Retinal fundus photograph · 848 x 848 pixels · without pupil dilation: 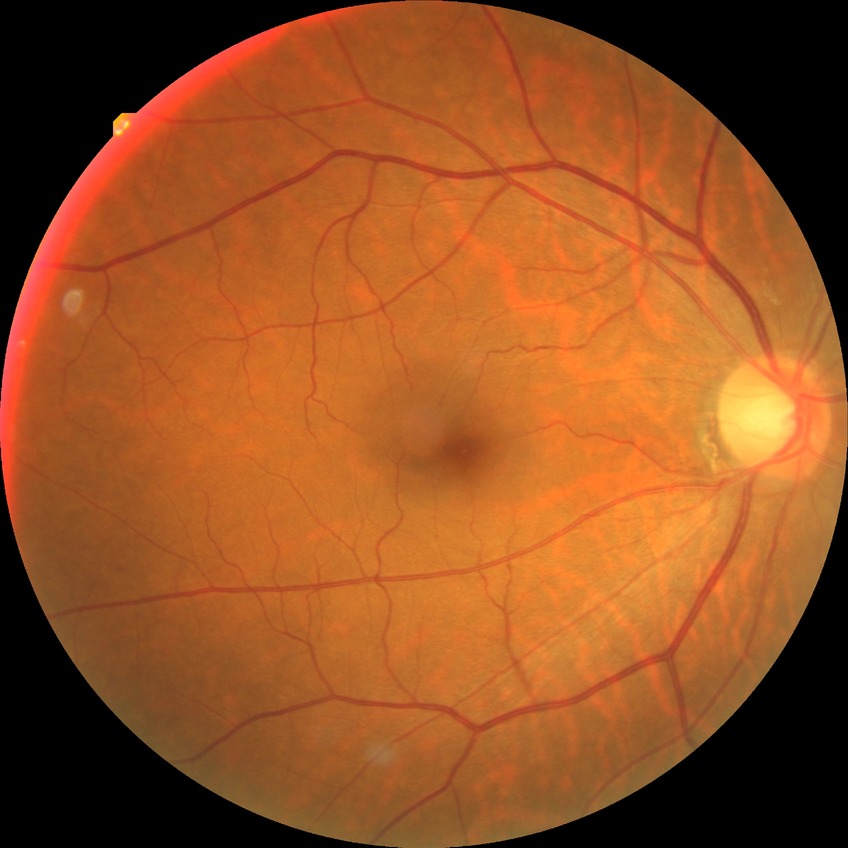 davis_grade: simple diabetic retinopathy (SDR)